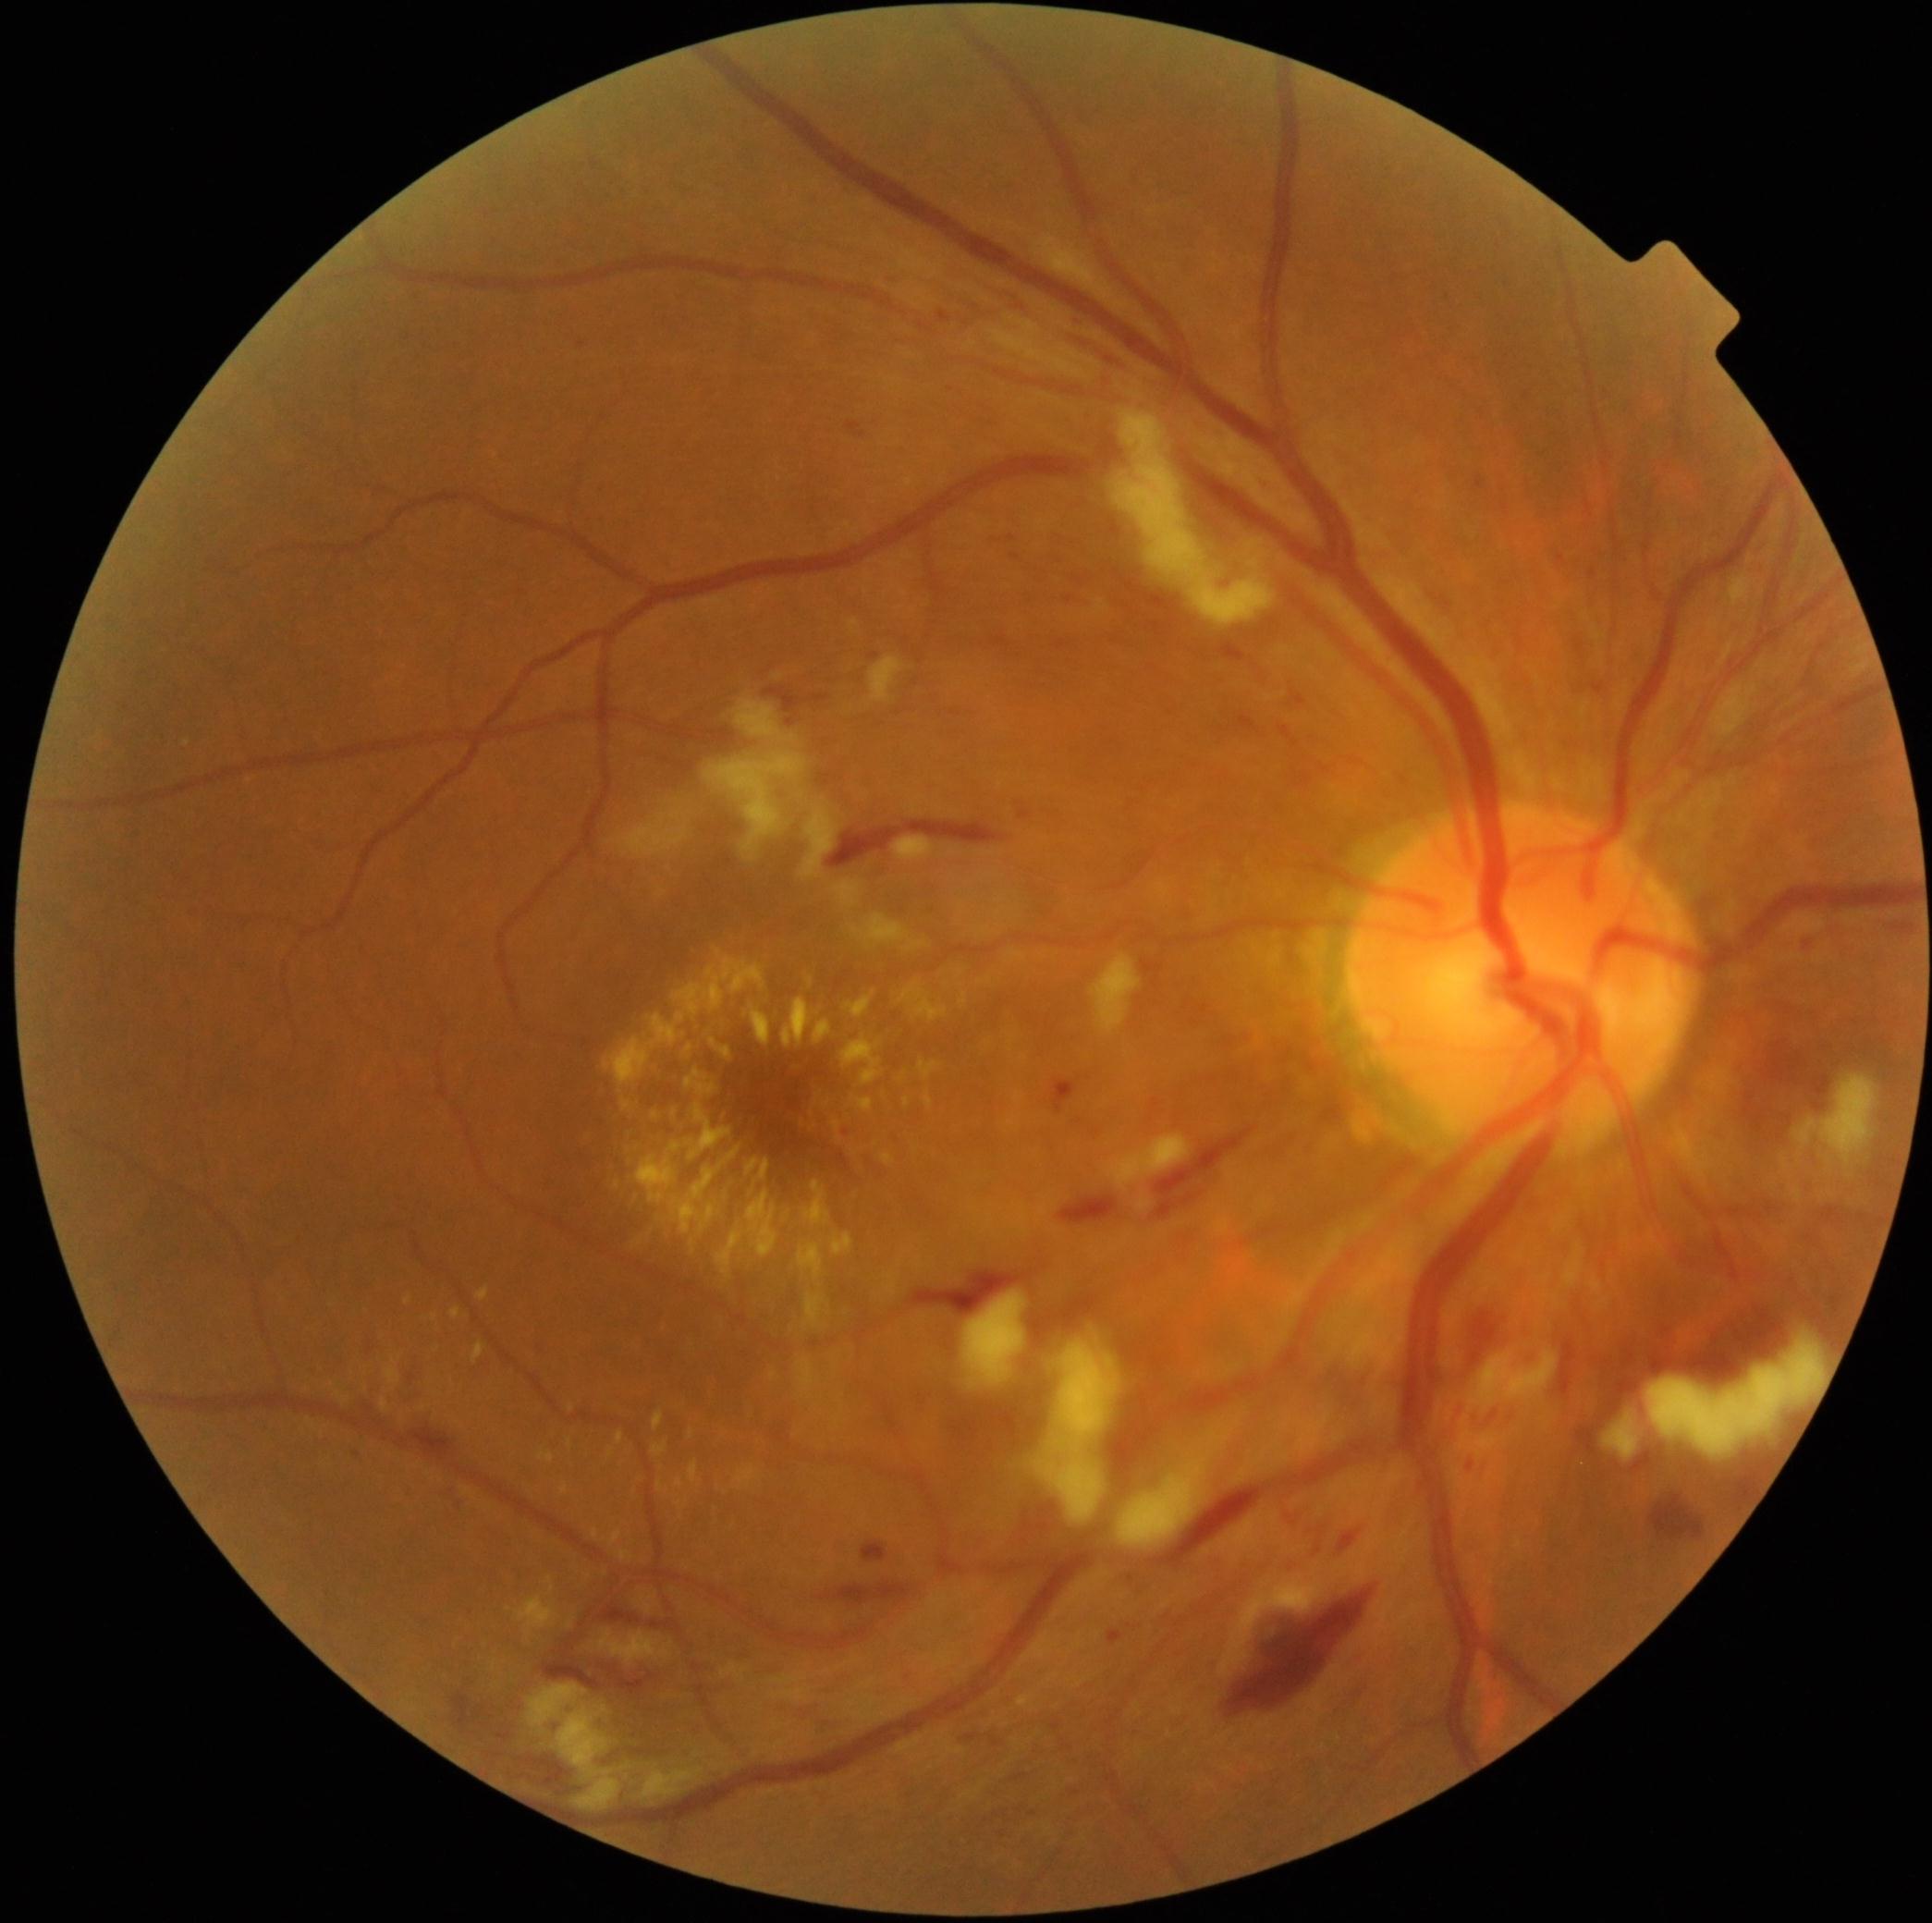
Diabetic retinopathy severity is grade 3
Representative lesions:
hard exudates (subset) = <bbox>516, 1596, 558, 1635</bbox>; <bbox>568, 1437, 573, 1448</bbox>; <bbox>594, 1629, 675, 1661</bbox>; <bbox>920, 1061, 940, 1080</bbox>; <bbox>710, 1038, 732, 1061</bbox>; <bbox>761, 1160, 770, 1181</bbox>; <bbox>381, 1400, 390, 1411</bbox>; <bbox>618, 1551, 631, 1555</bbox>; <bbox>657, 1482, 663, 1491</bbox>; <bbox>538, 1450, 555, 1464</bbox>; <bbox>746, 1003, 772, 1045</bbox>; <bbox>547, 1575, 555, 1594</bbox>; <bbox>834, 1121, 841, 1131</bbox>
Small hard exudates approximately at point(618, 1184); point(817, 1014); point(572, 1408)
hemorrhages (subset) = <bbox>862, 1541, 887, 1562</bbox>; <bbox>1156, 1128, 1254, 1219</bbox>; <bbox>598, 1660, 669, 1693</bbox>; <bbox>825, 775, 832, 786</bbox>; <bbox>1060, 1195, 1118, 1224</bbox>; <bbox>1621, 1351, 1638, 1372</bbox>; <bbox>1339, 1532, 1360, 1551</bbox>; <bbox>1290, 691, 1307, 707</bbox>; <bbox>1322, 1349, 1376, 1426</bbox>; <bbox>1632, 1451, 1653, 1475</bbox>; <bbox>1335, 1676, 1367, 1716</bbox>; <bbox>1019, 809, 1032, 820</bbox>; <bbox>405, 1429, 456, 1446</bbox>; <bbox>452, 1693, 471, 1729</bbox>